Modified Davis grading.
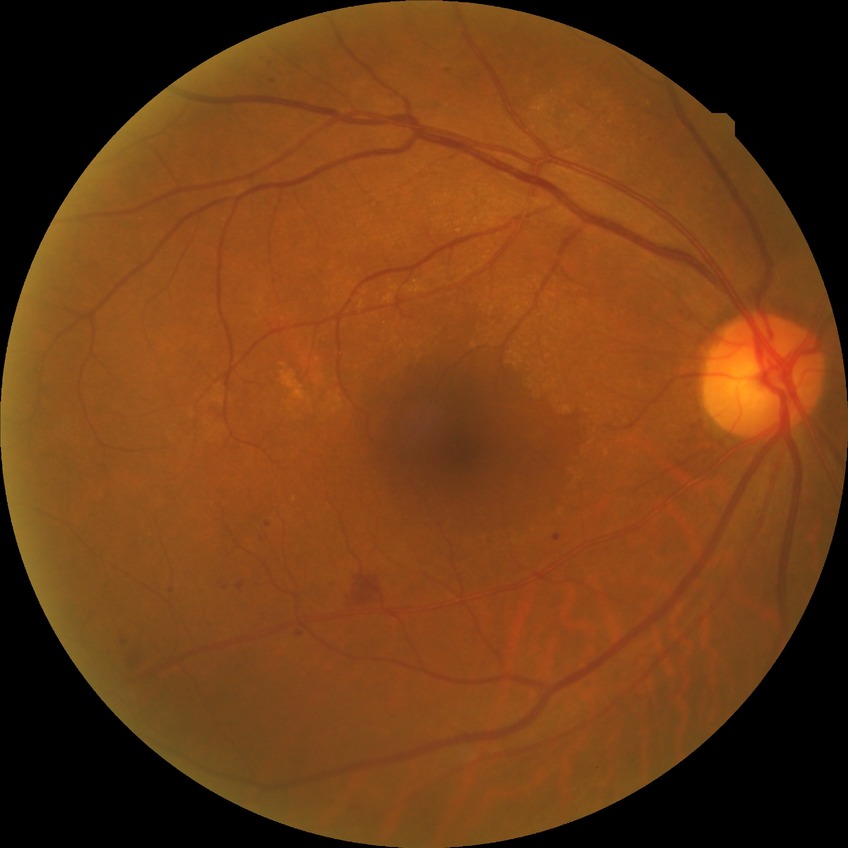

Diabetic retinopathy (DR) is SDR (simple diabetic retinopathy). Disease class: non-proliferative diabetic retinopathy.